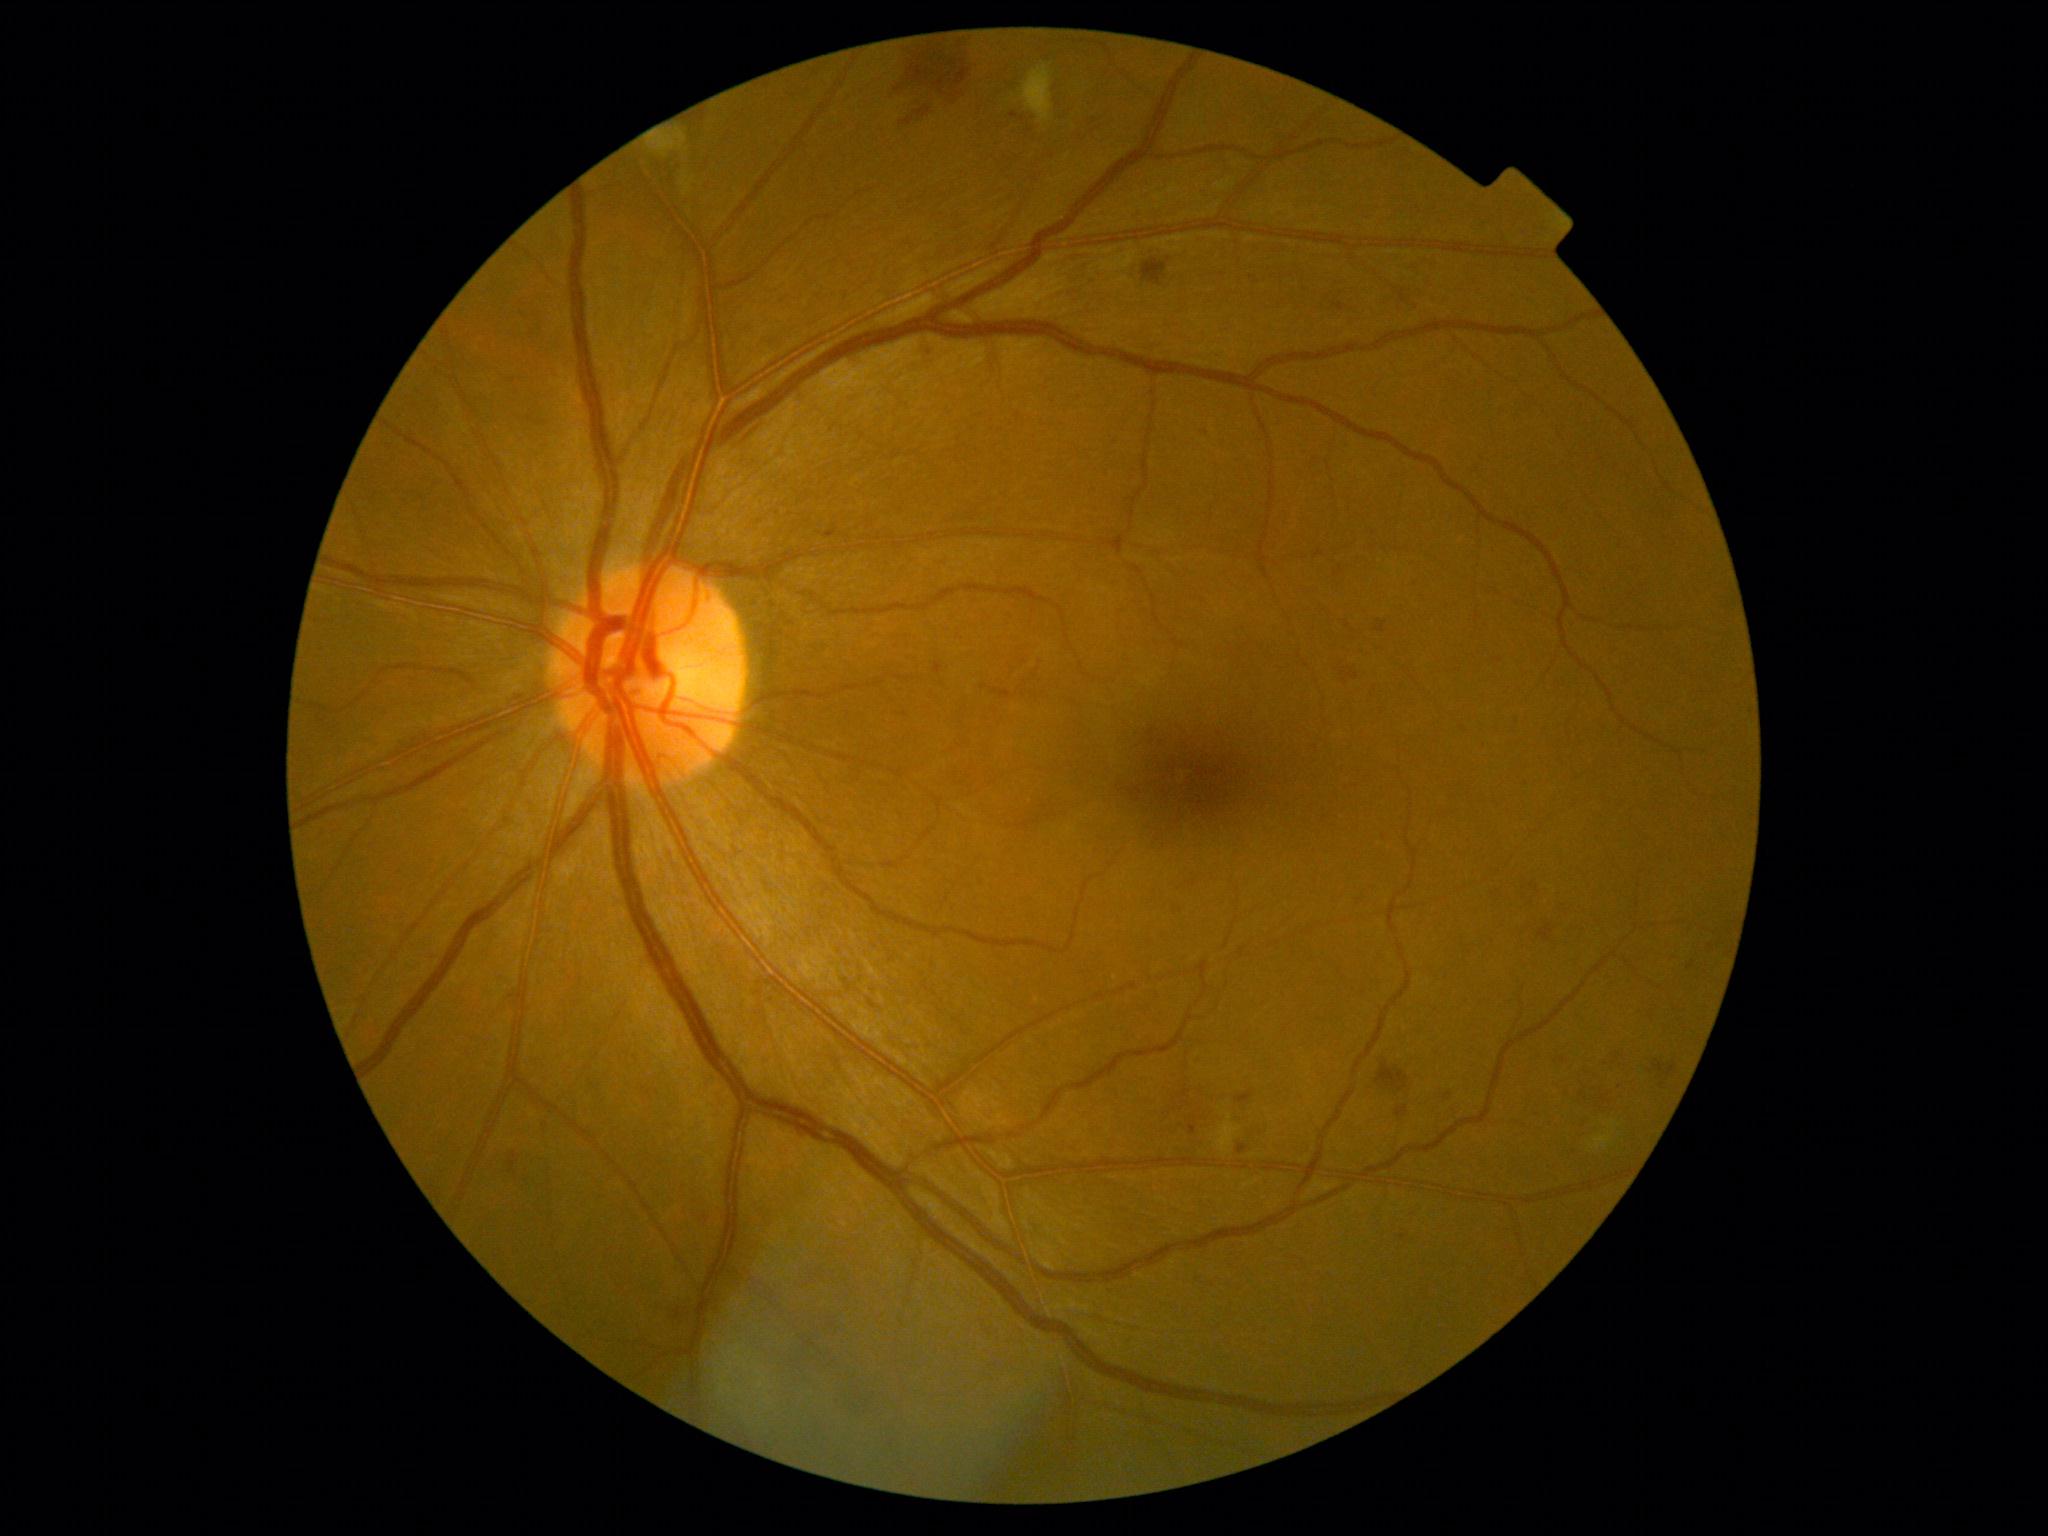

DR severity is moderate non-proliferative diabetic retinopathy (grade 2).